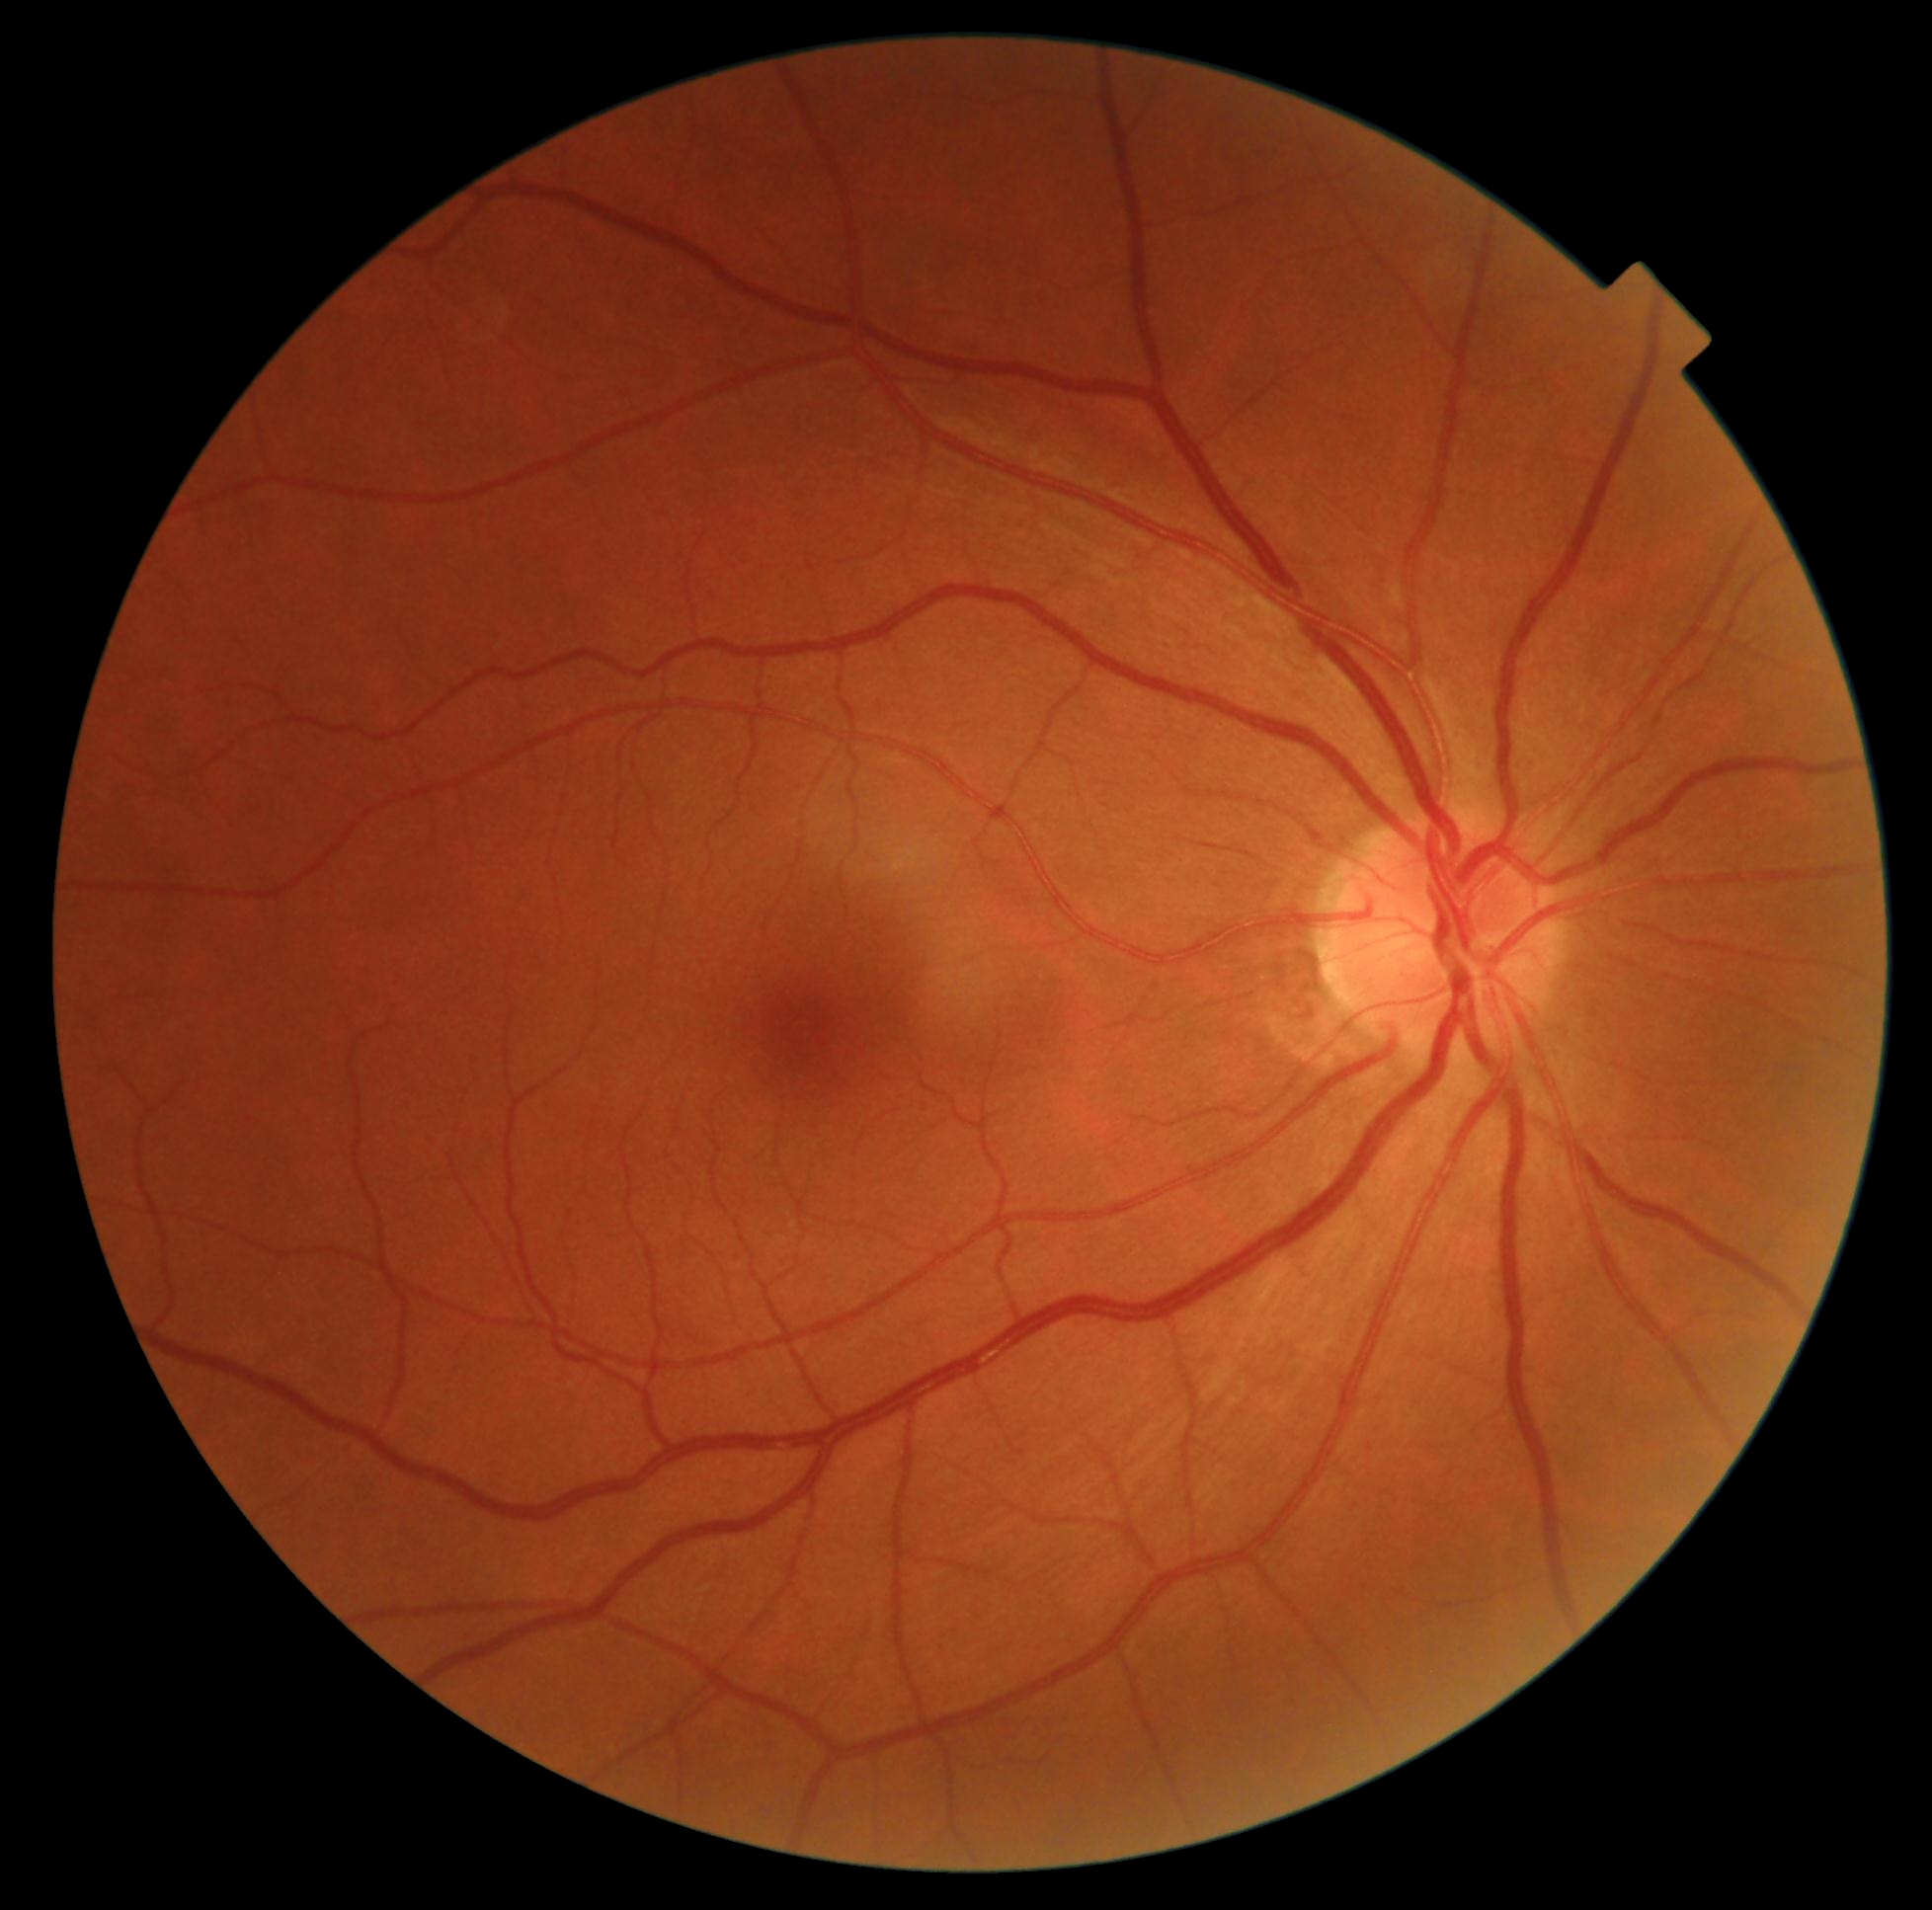
Diabetic retinopathy severity: grade 0 (no apparent retinopathy) — no visible signs of diabetic retinopathy.